Acquired with a NIDEK AFC-230 · 848x848px — 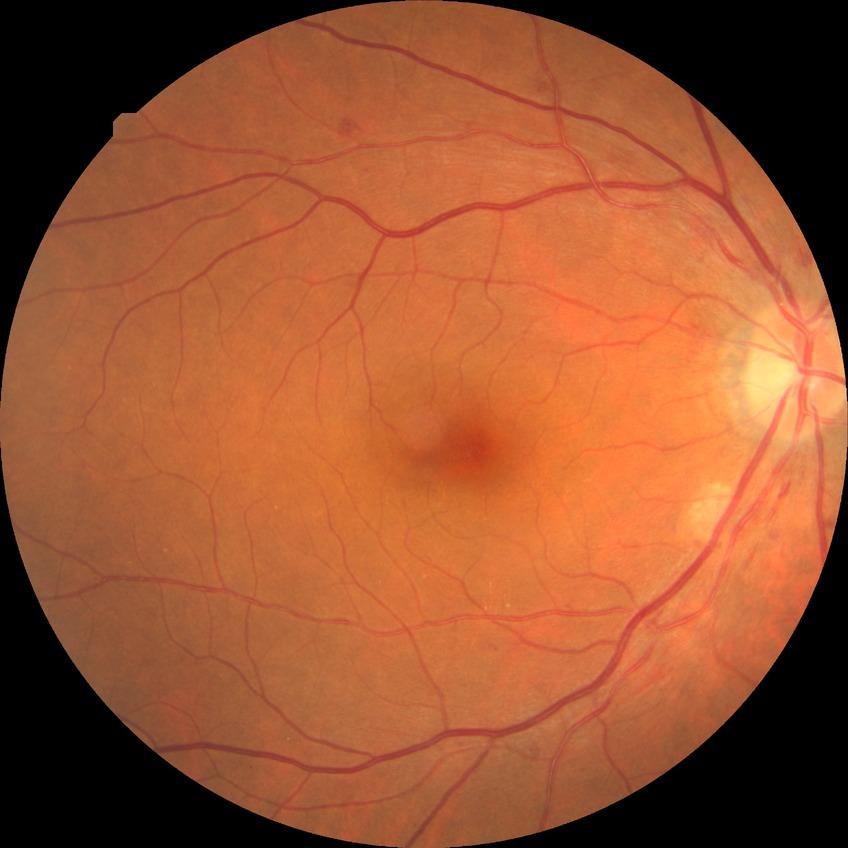 diabetic retinopathy severity = simple diabetic retinopathy